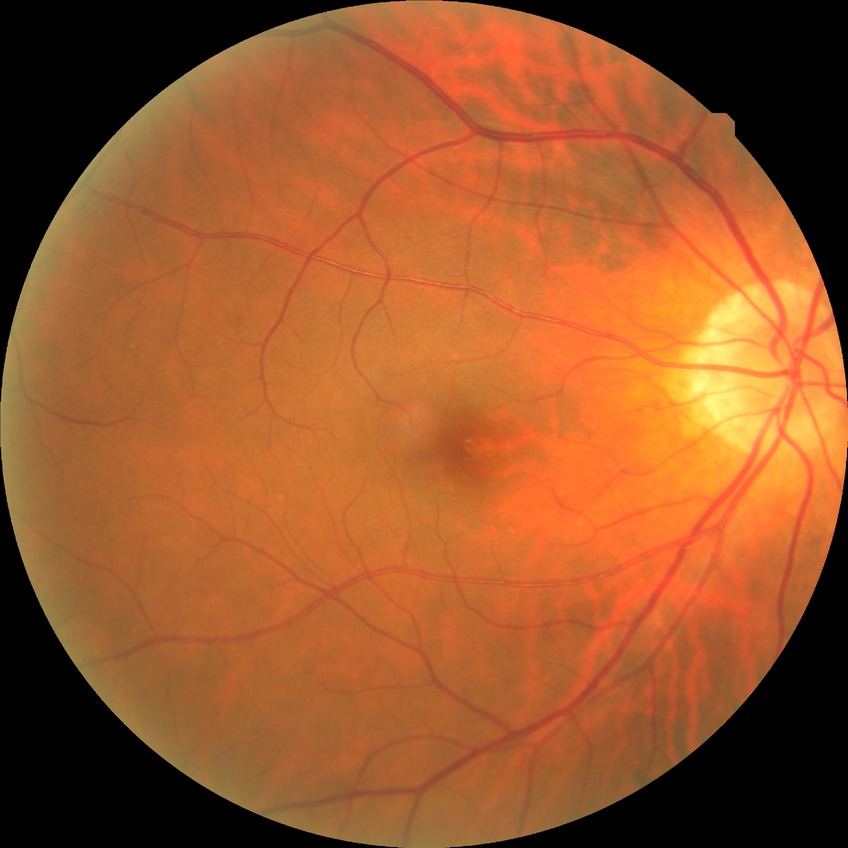
Modified Davis classification: no diabetic retinopathy.